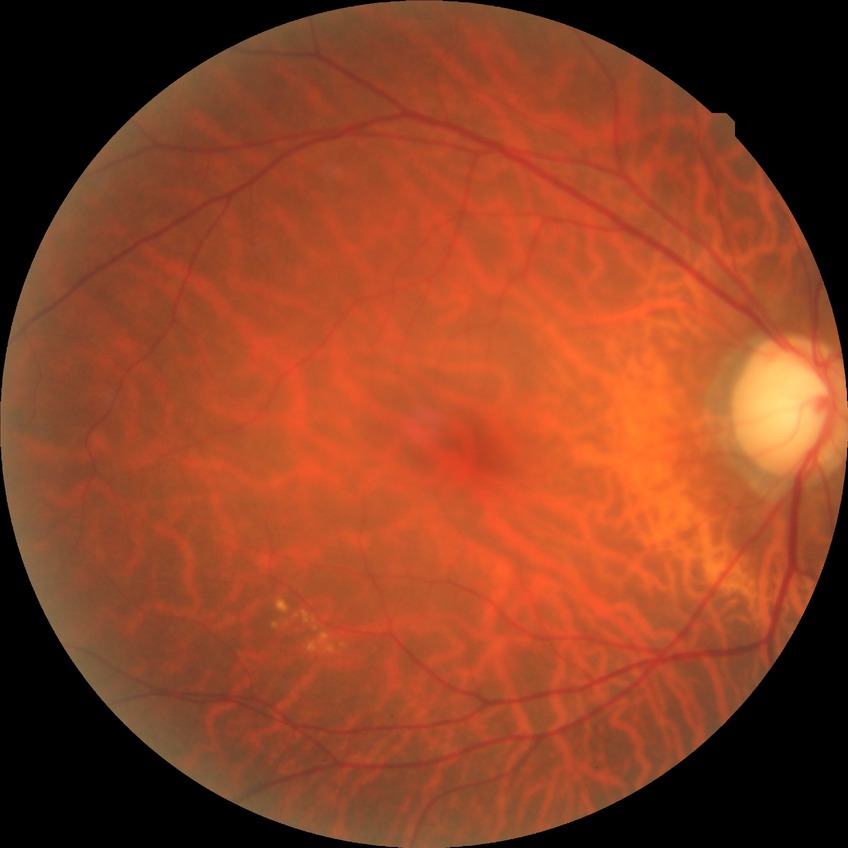 Retinopathy stage: no diabetic retinopathy.